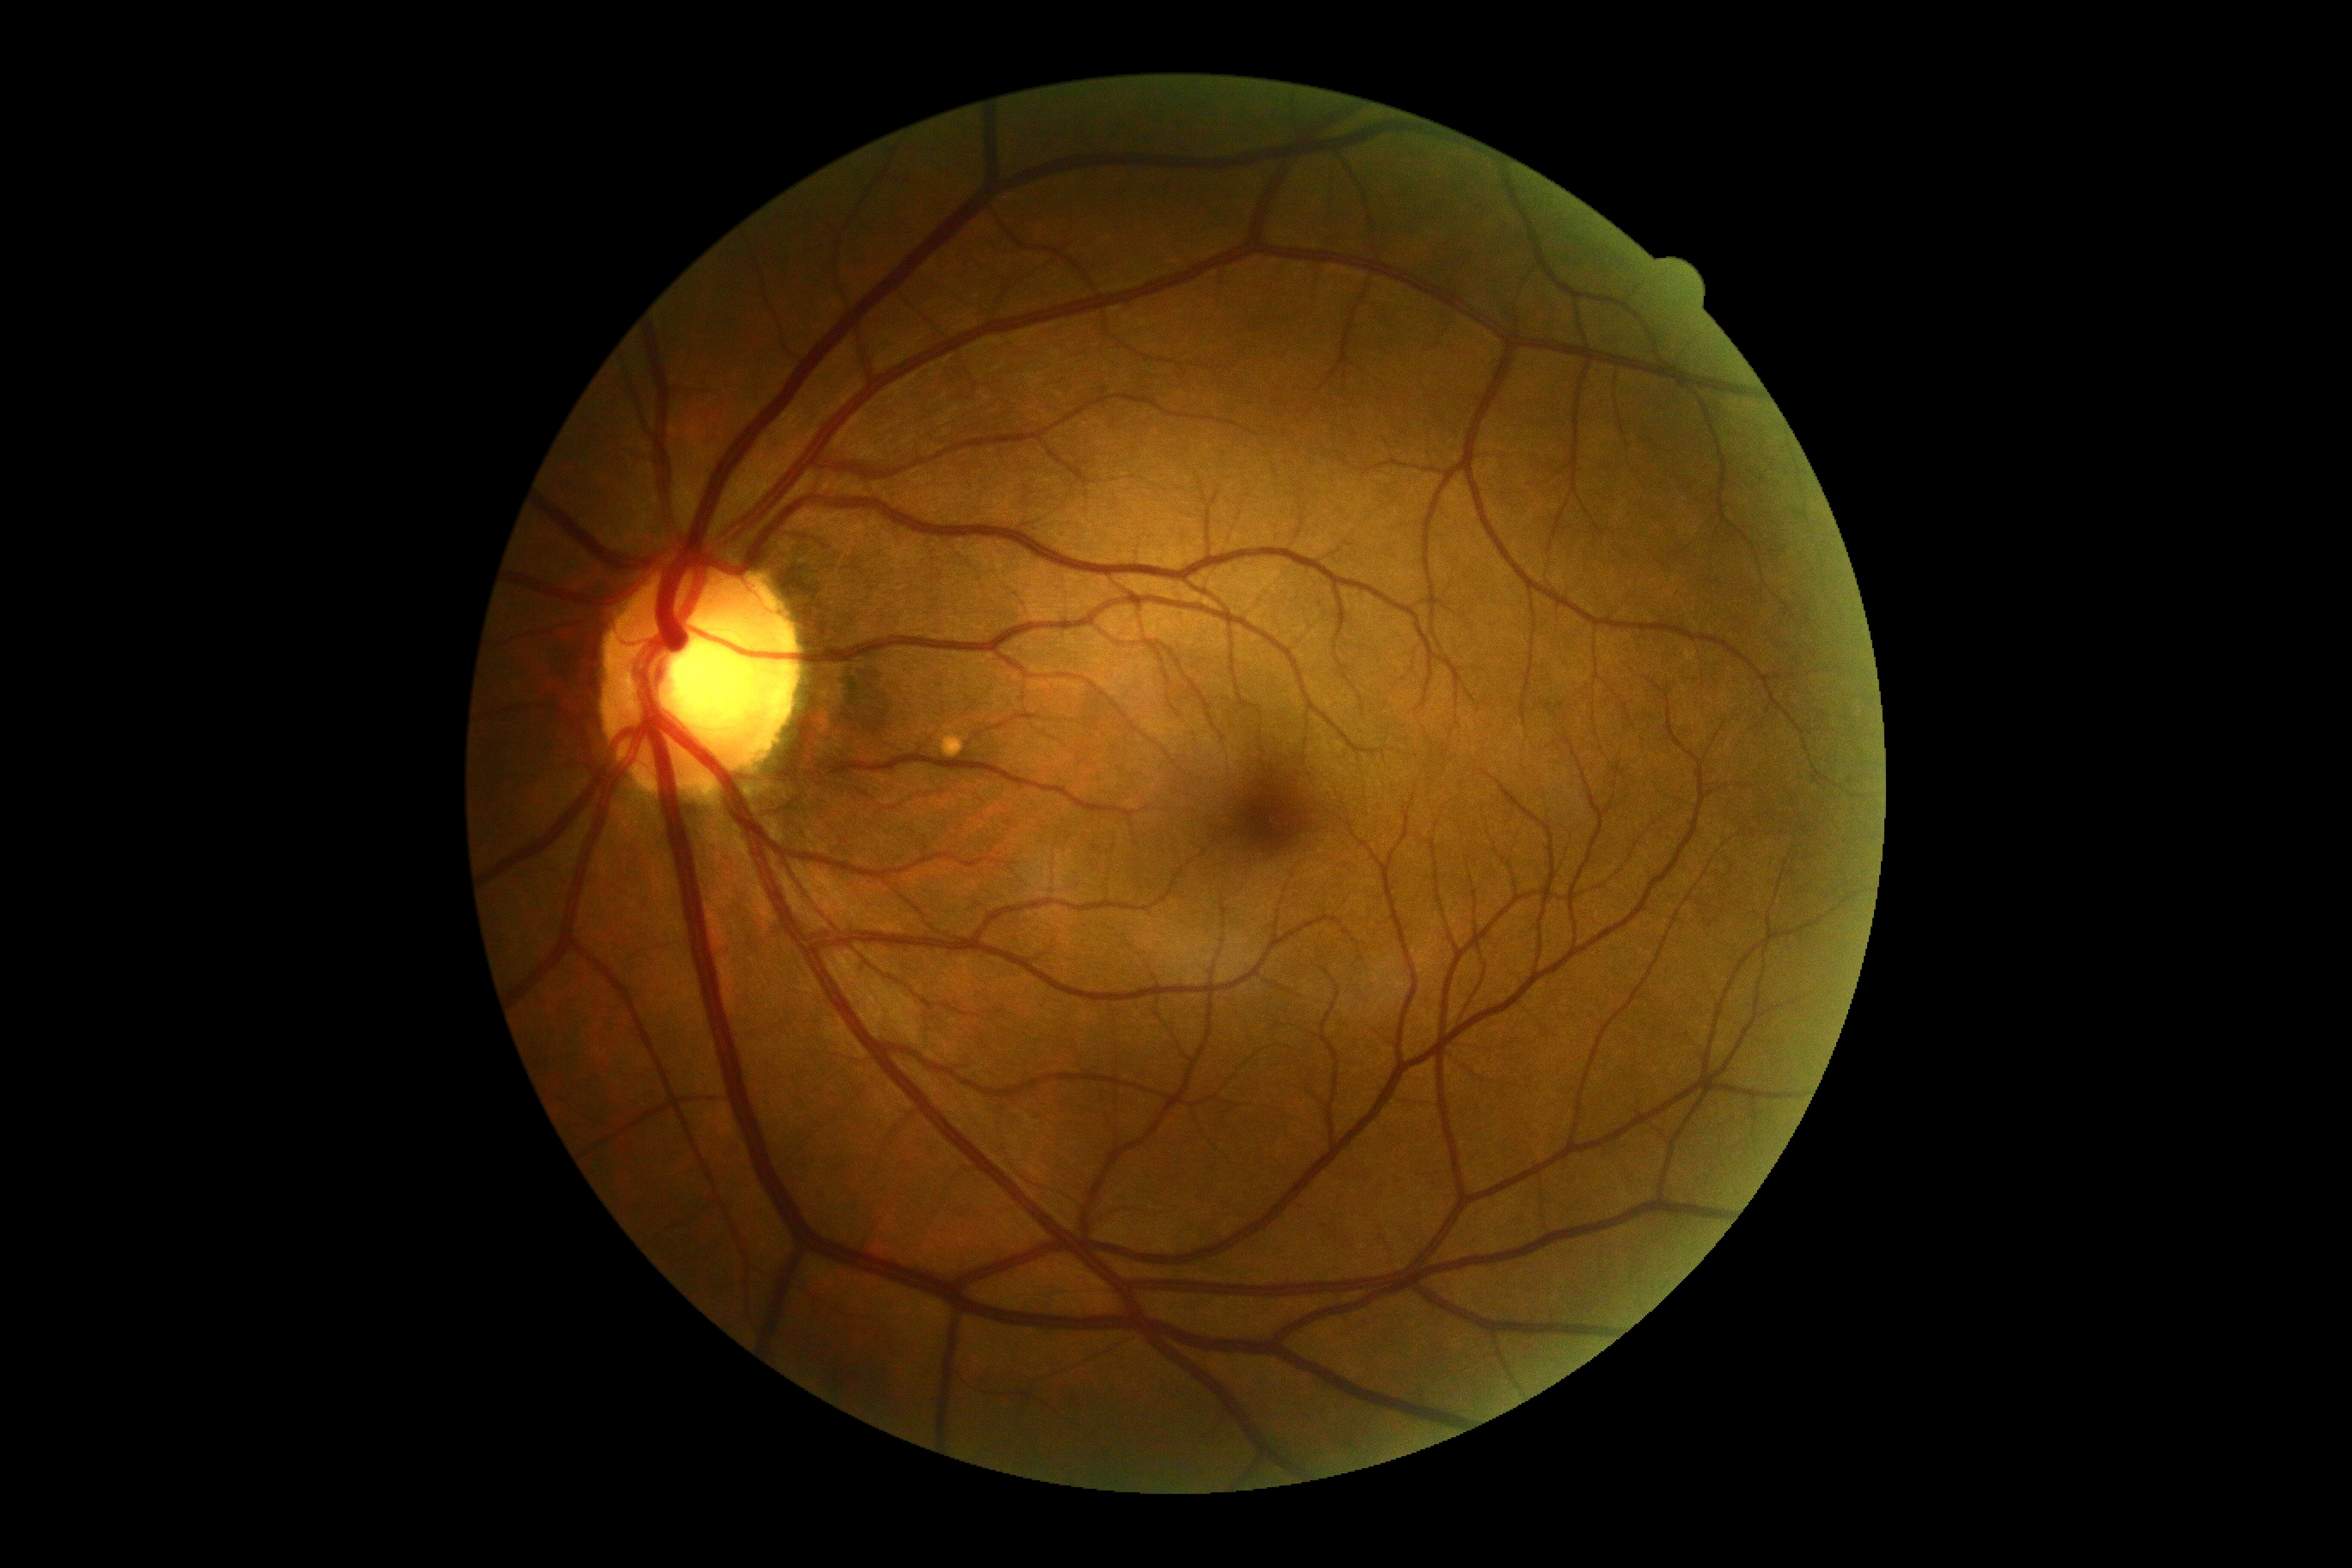

DR stage: grade 0.